45 degree fundus photograph:
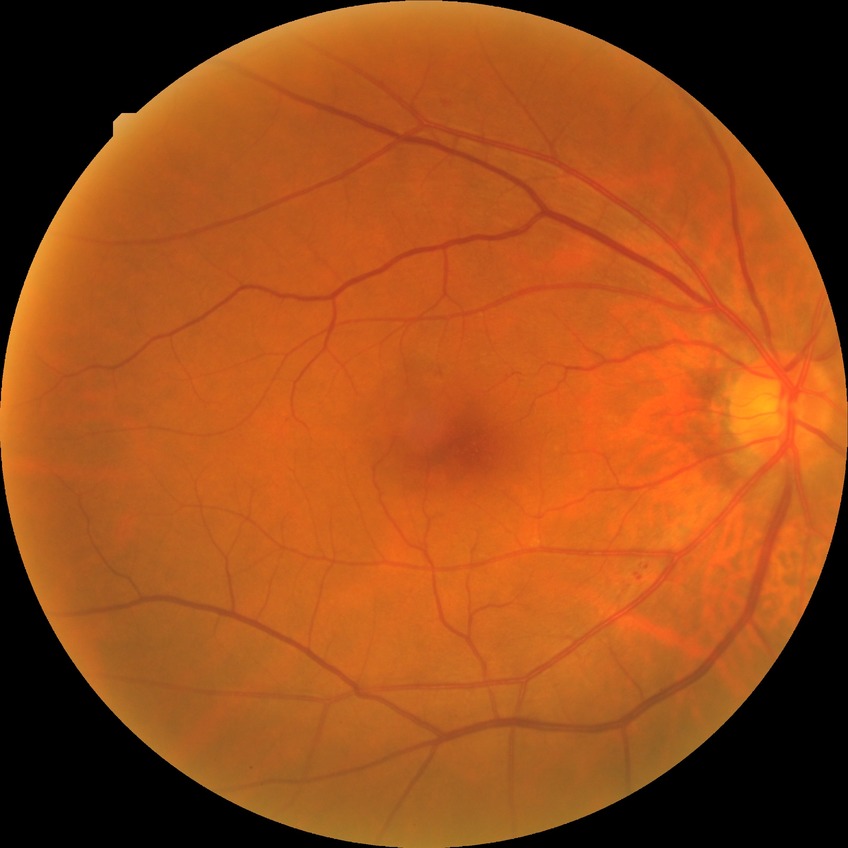 Diabetic retinopathy (DR): NDR (no diabetic retinopathy).